Color fundus image: 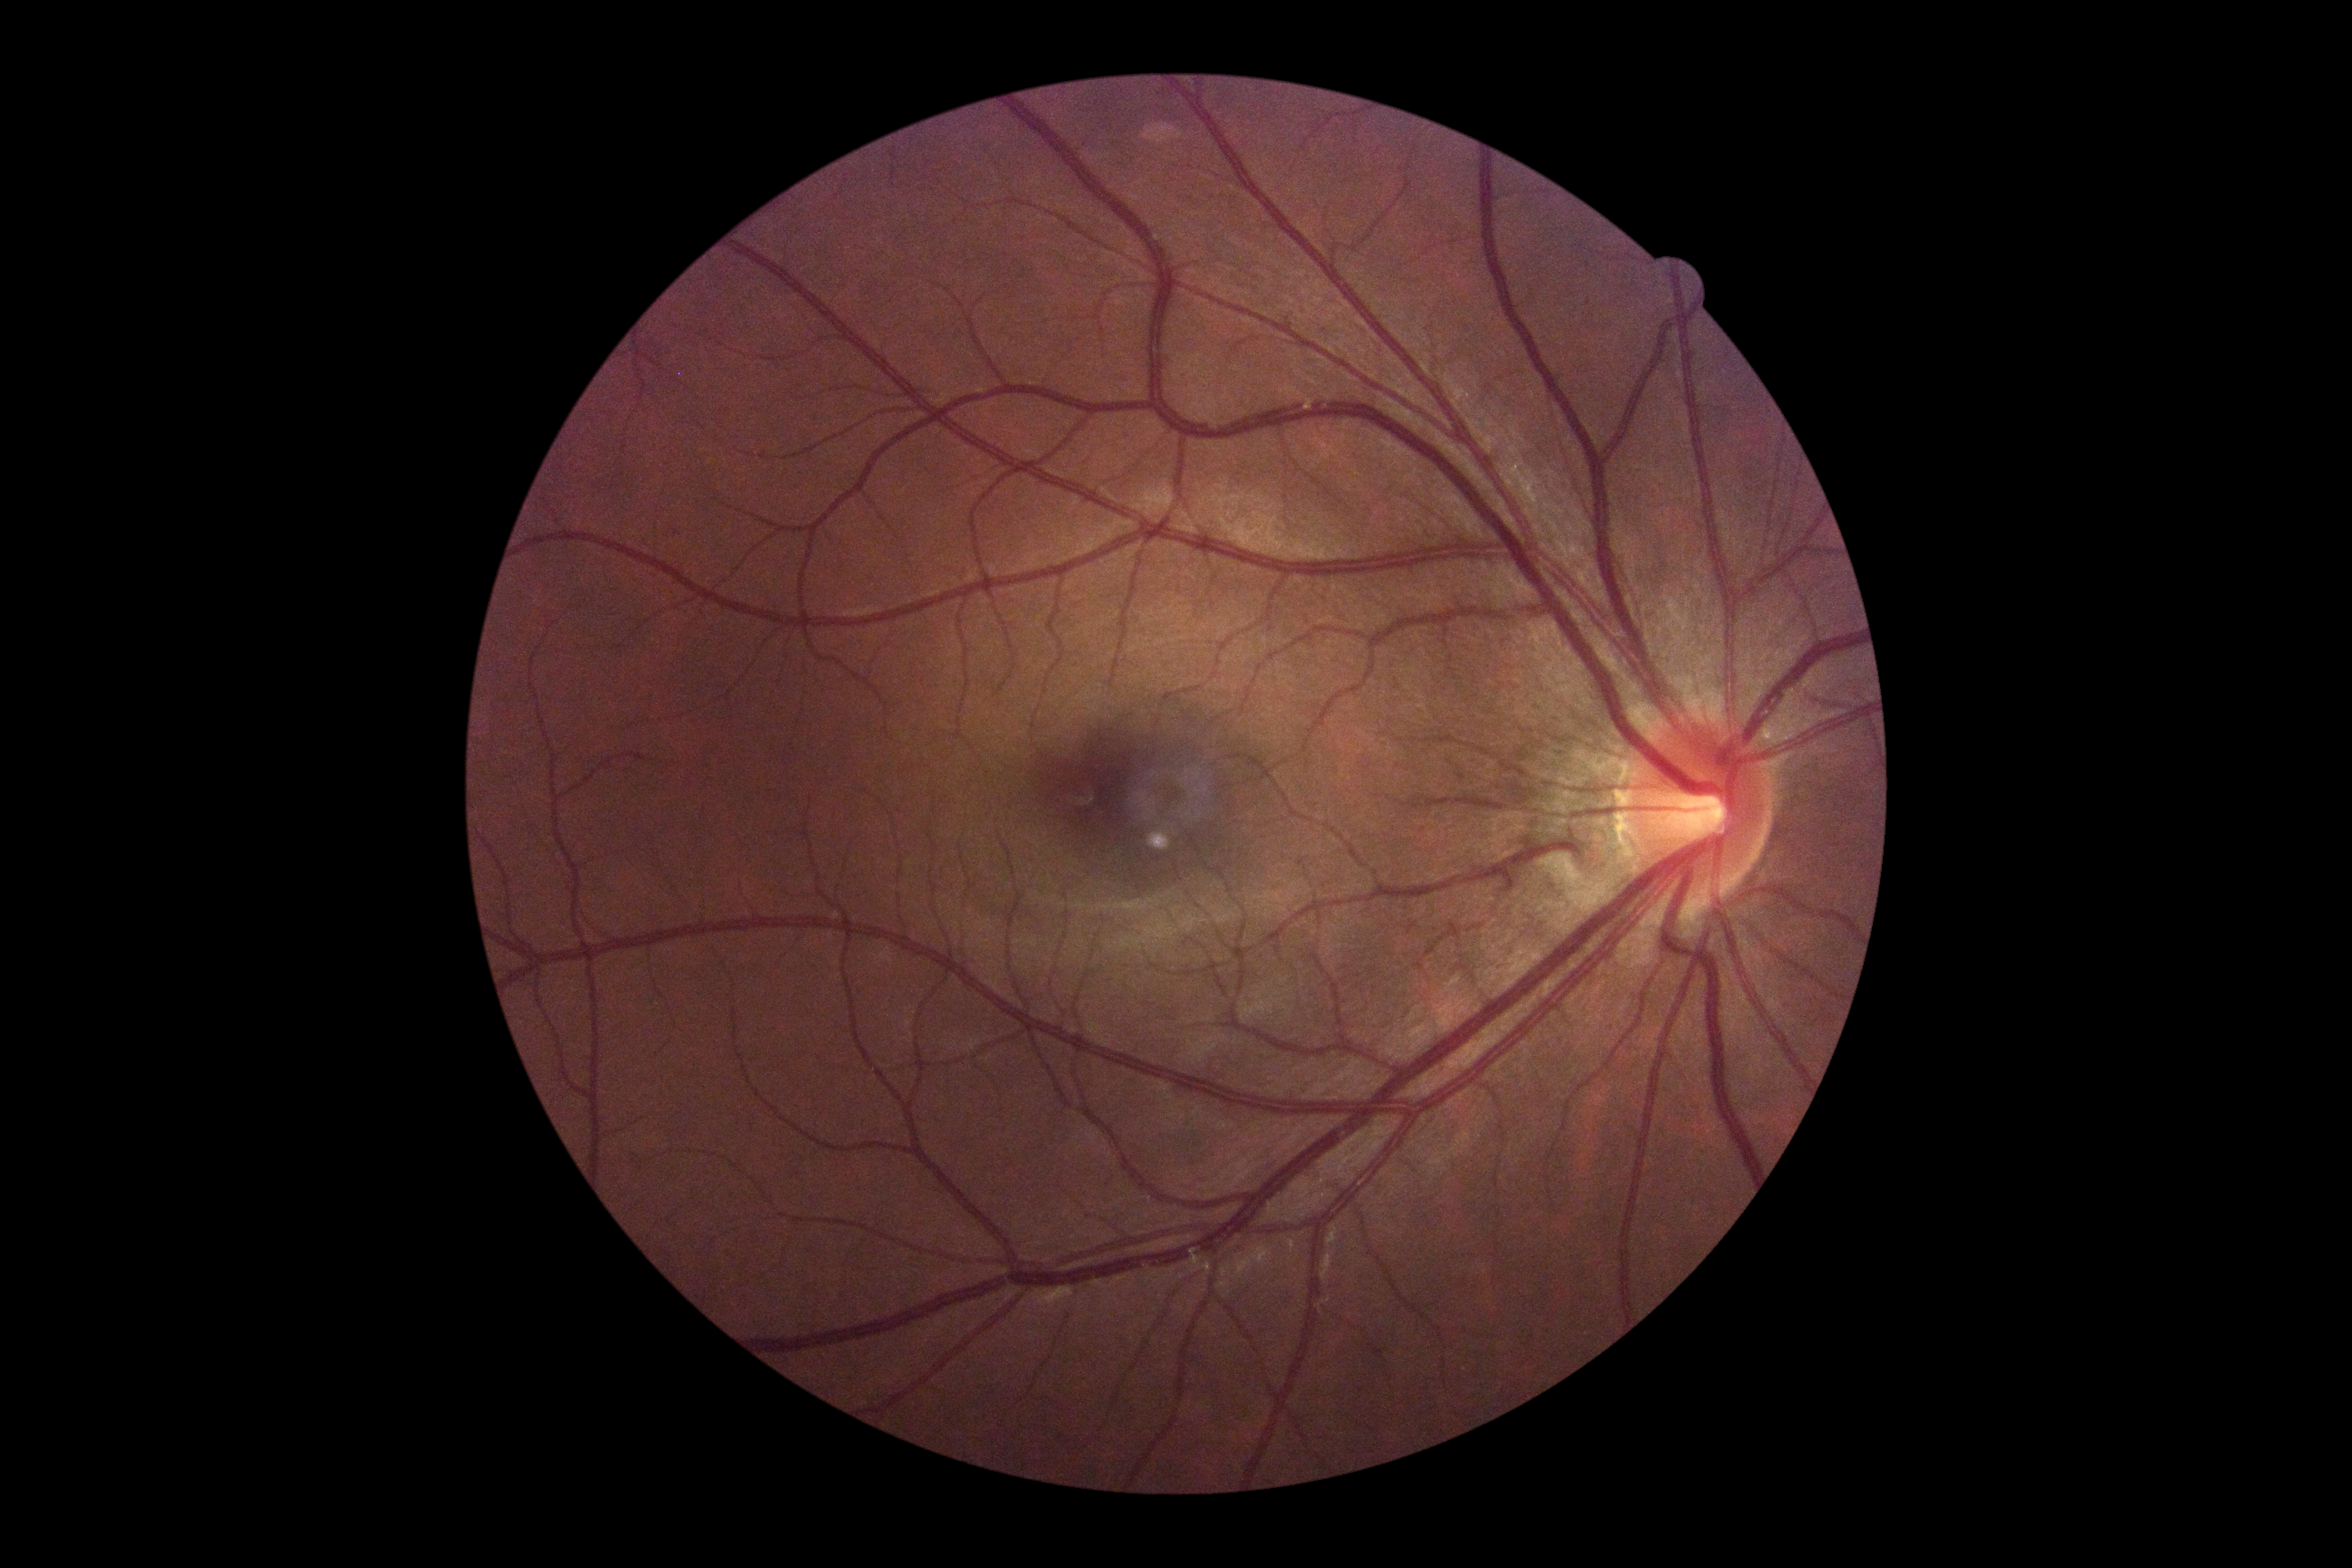
diabetic retinopathy = 0.